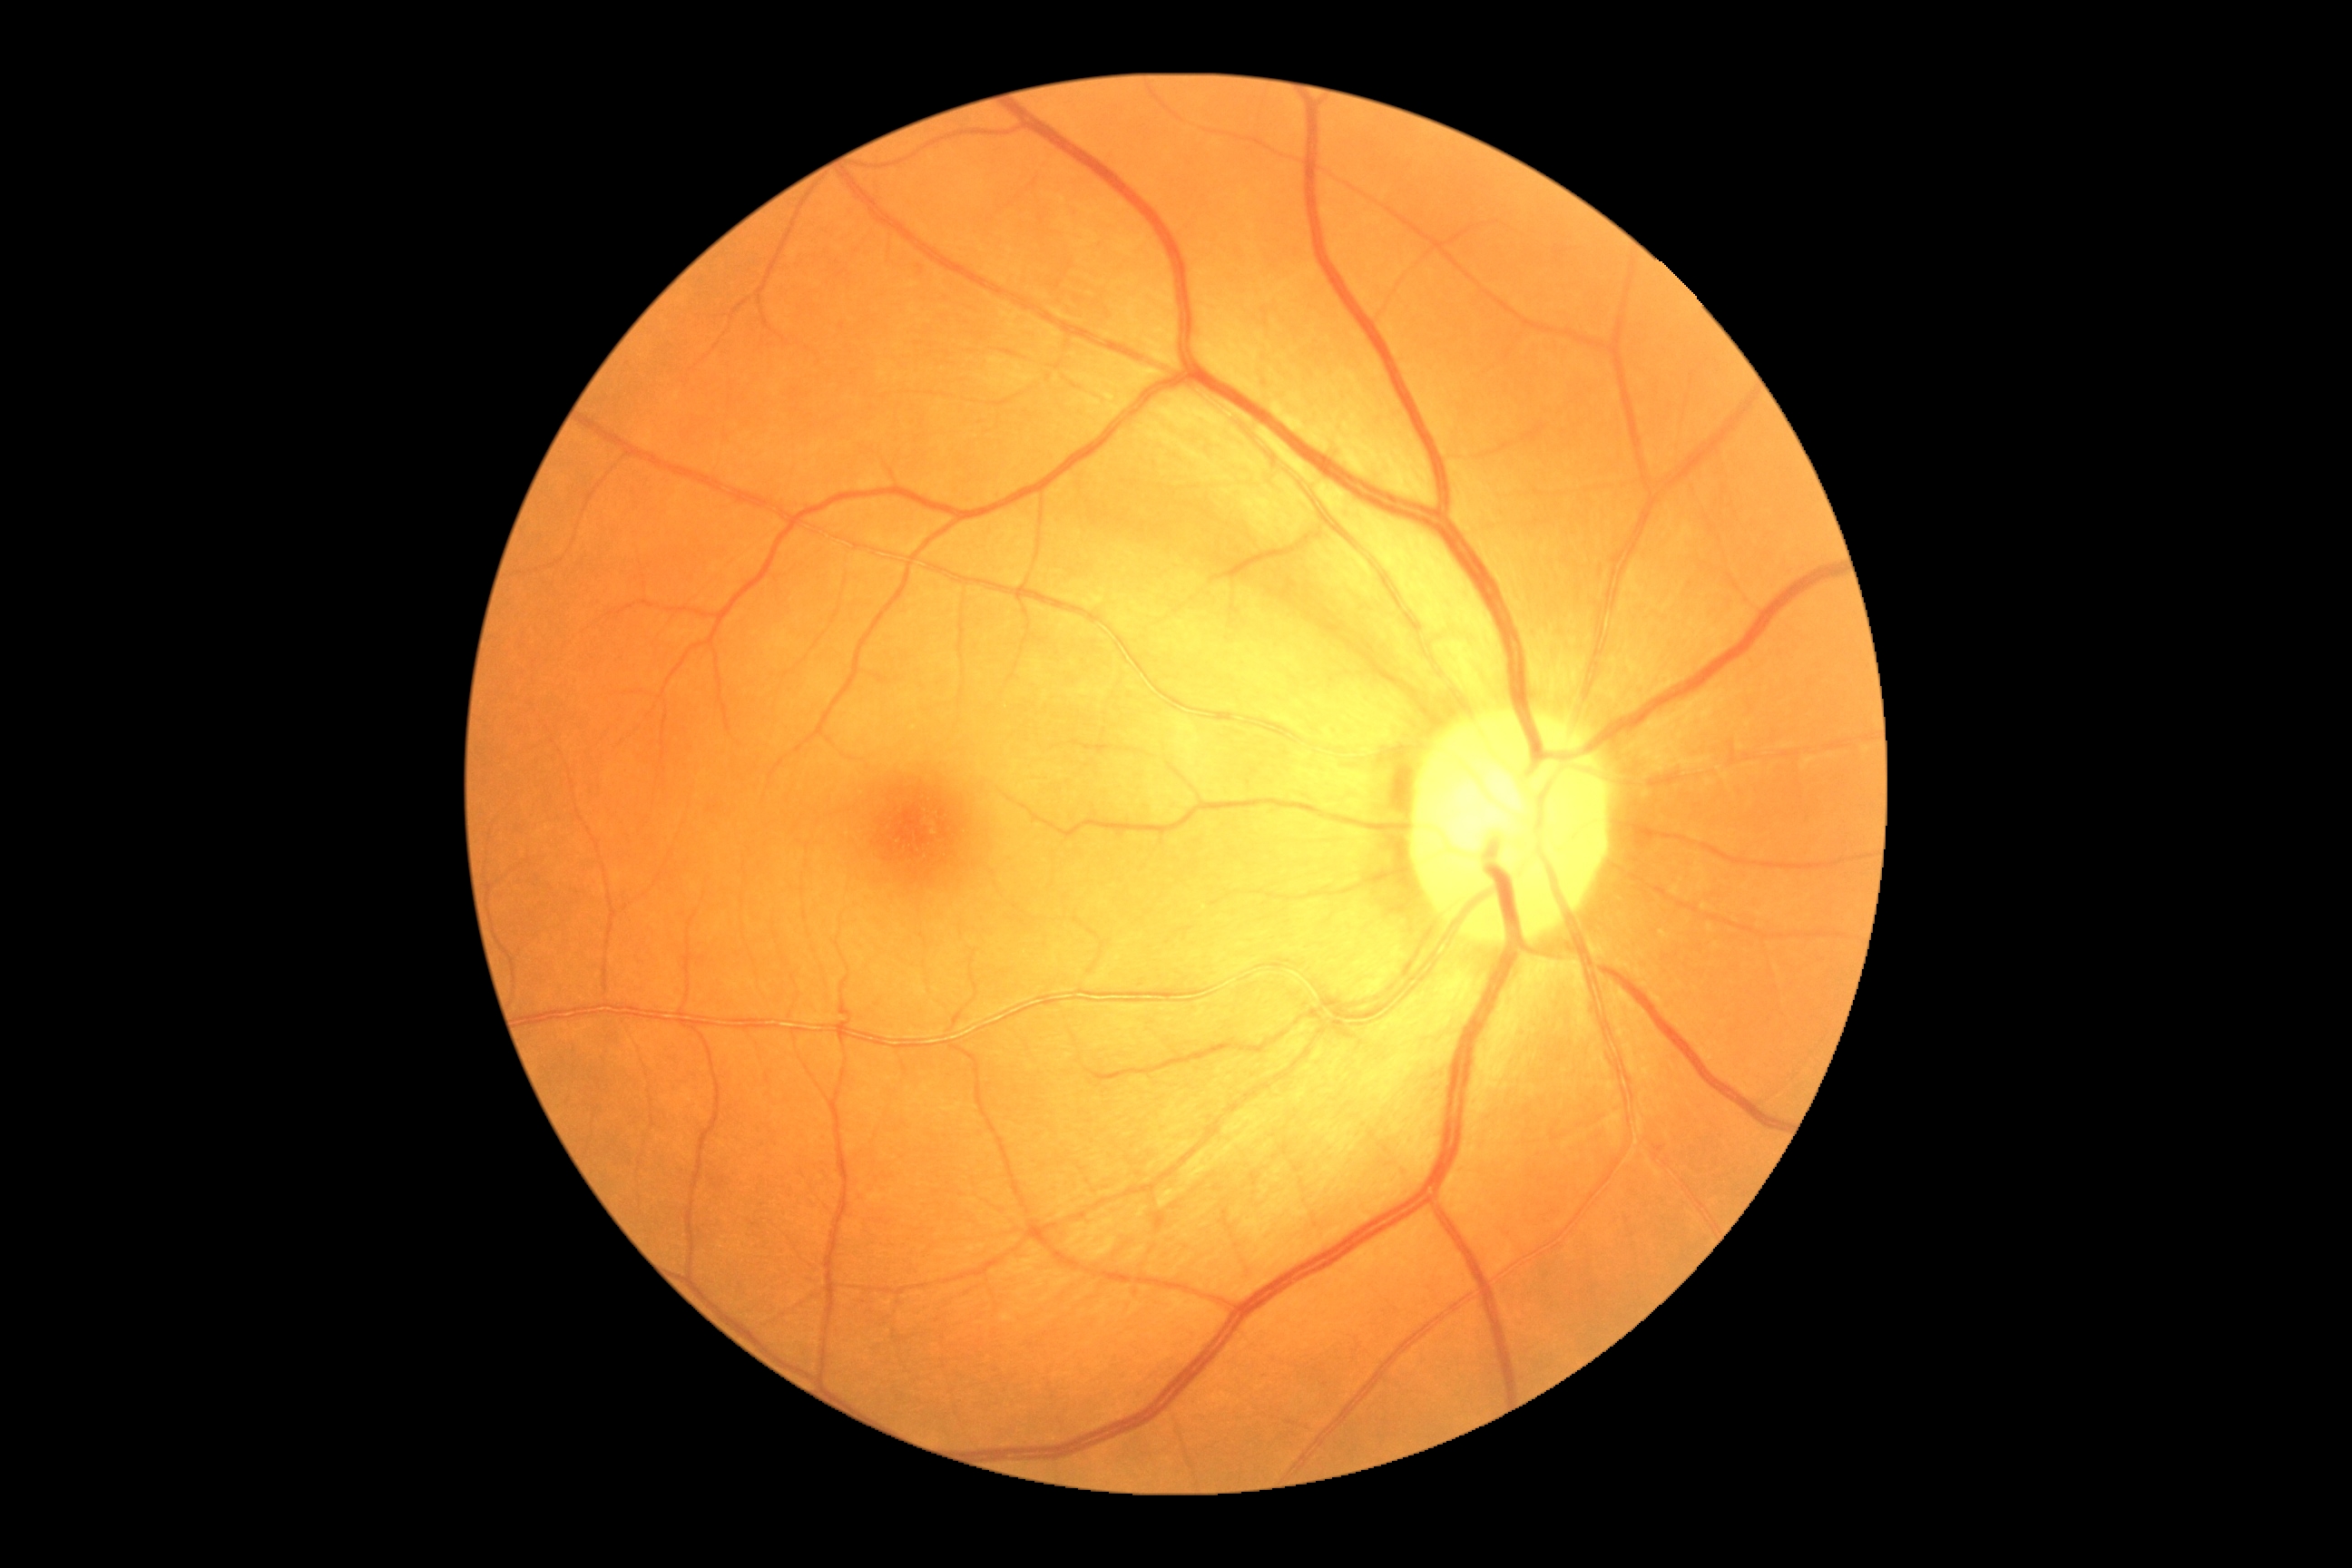
Diabetic retinopathy: no apparent diabetic retinopathy (grade 0).